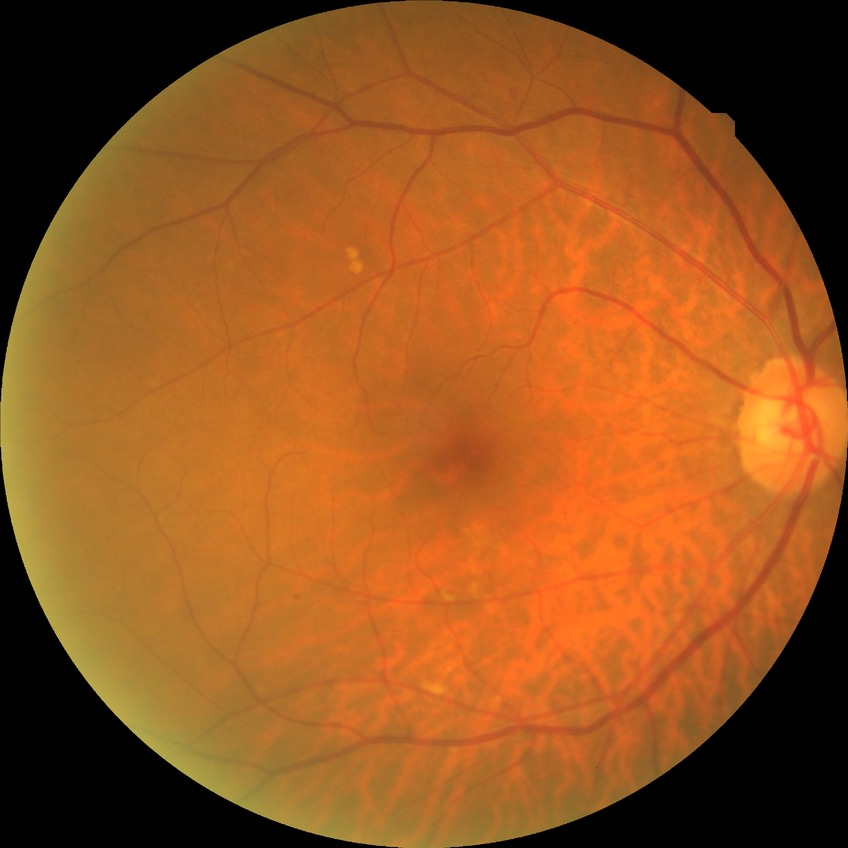
The retinopathy is classified as non-proliferative diabetic retinopathy. Modified Davis classification is simple diabetic retinopathy.